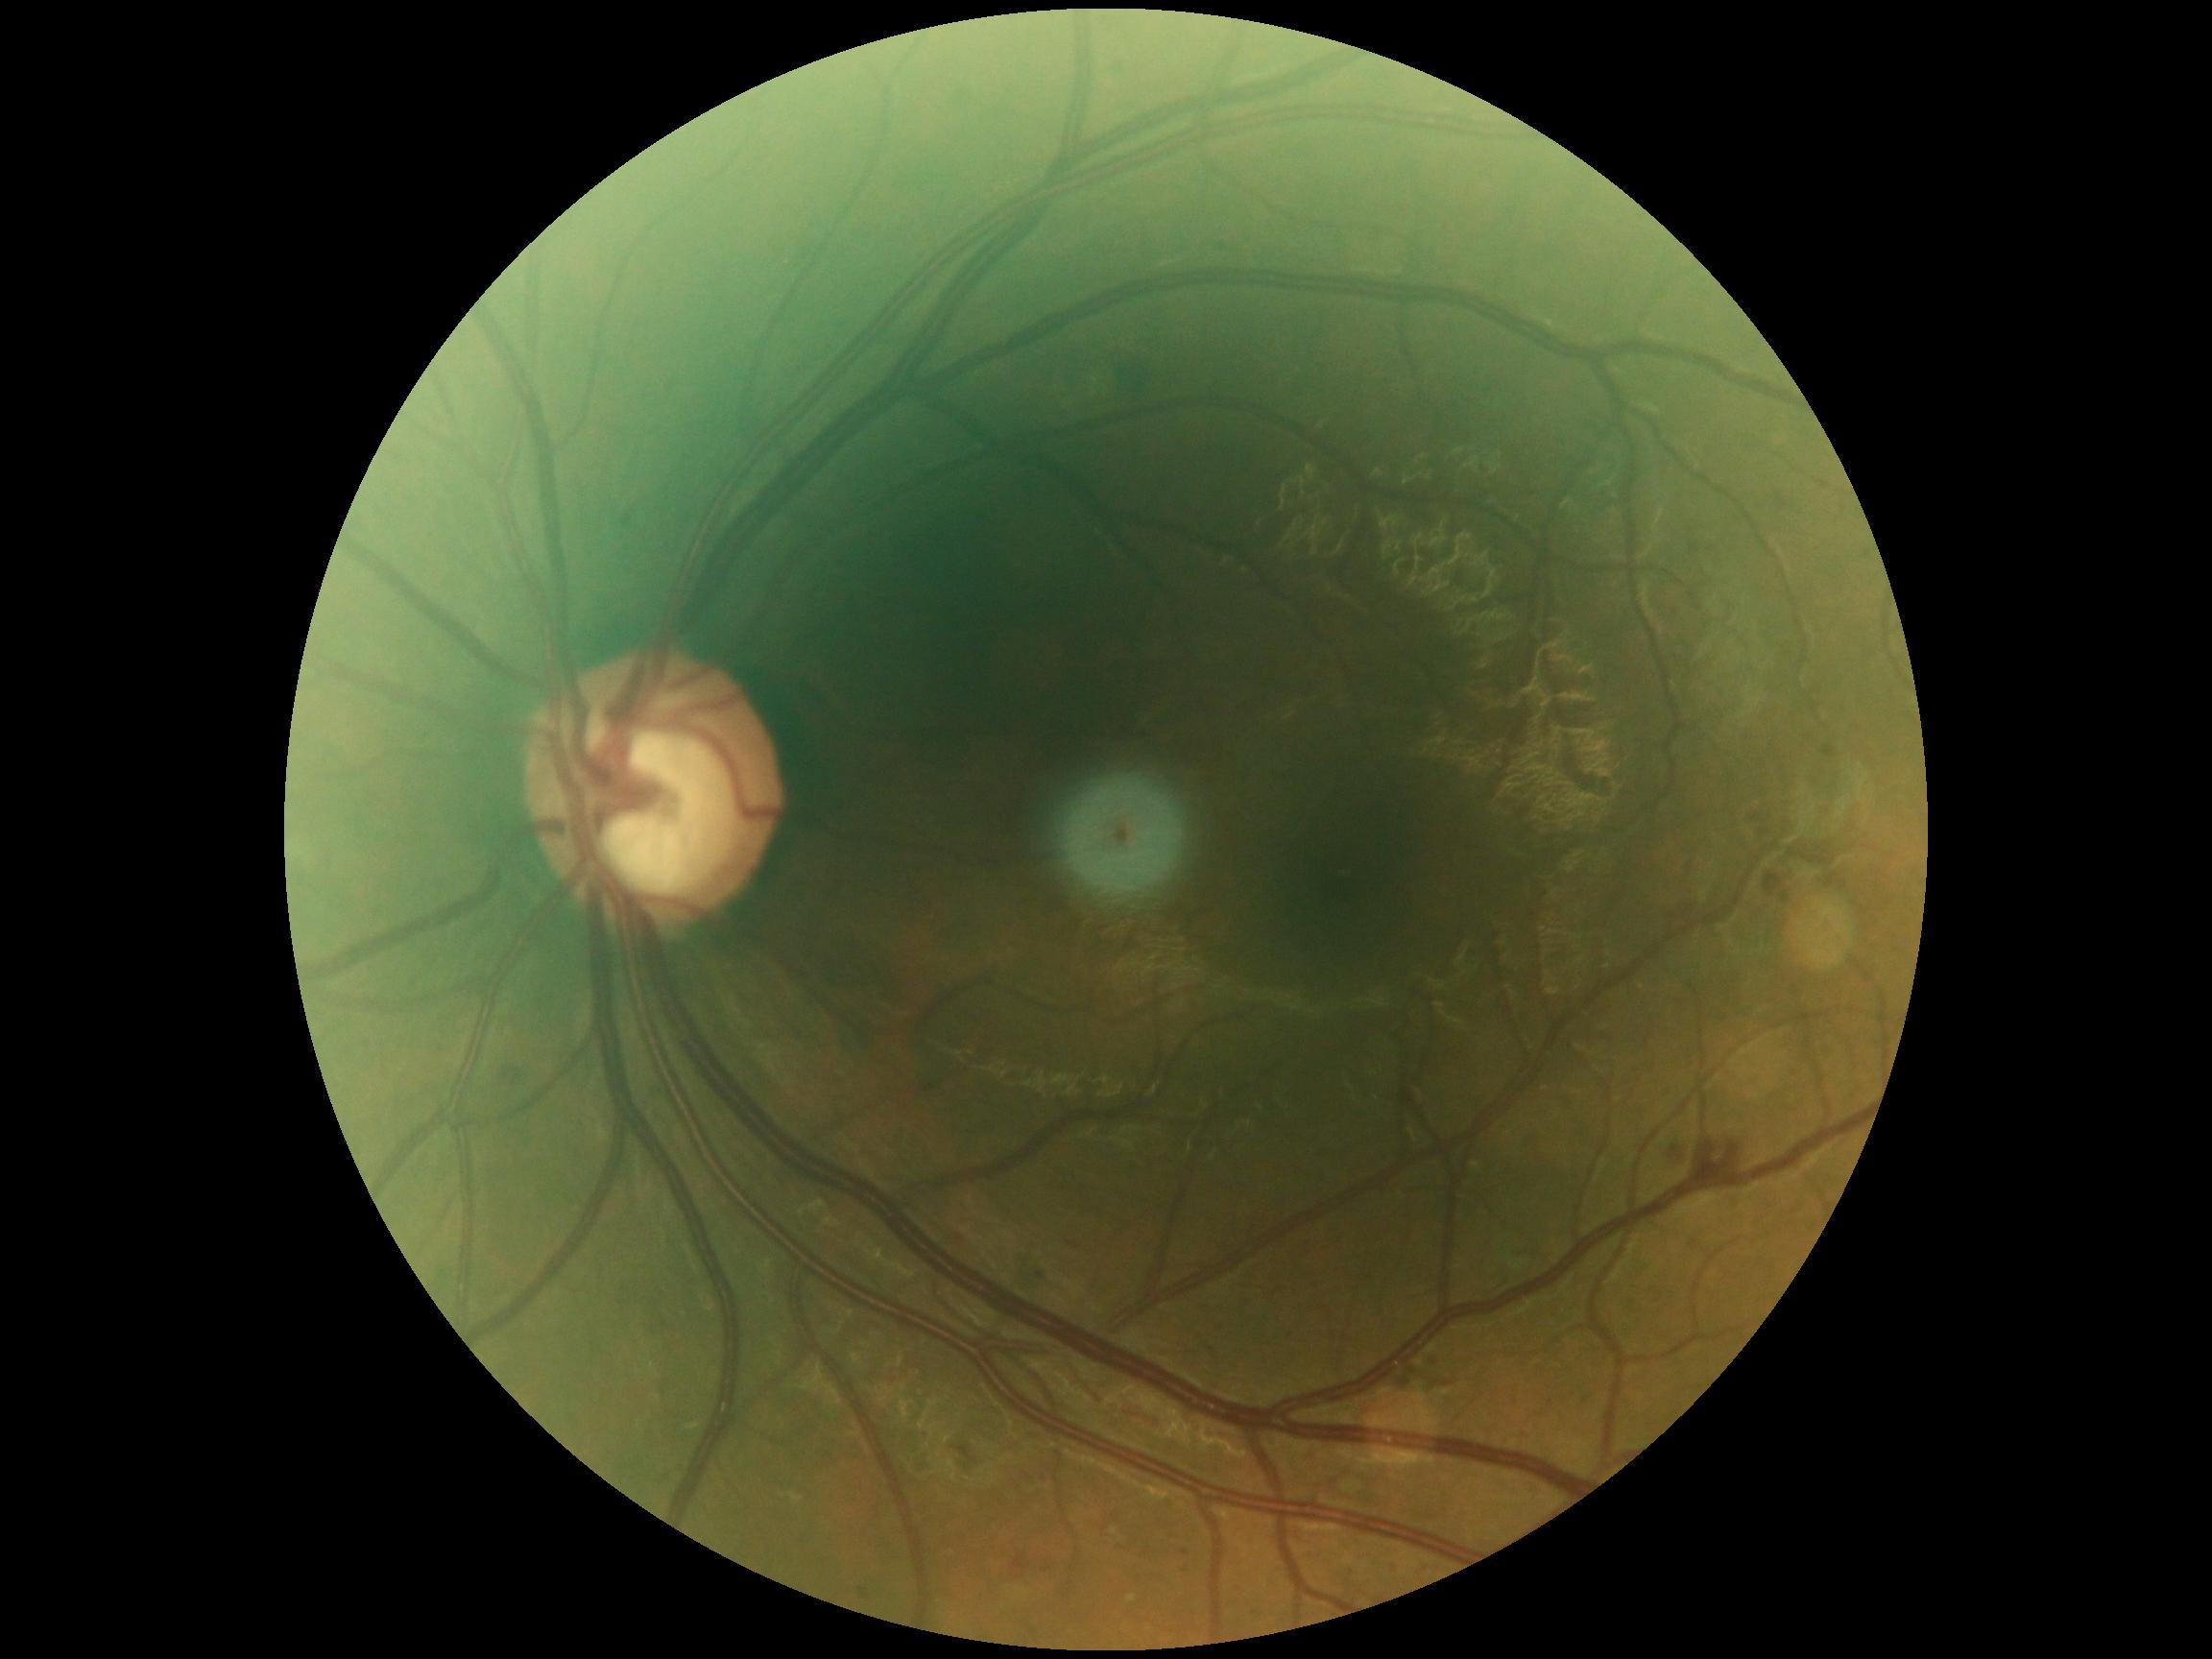 DR class: non-proliferative diabetic retinopathy; DR: moderate non-proliferative diabetic retinopathy (grade 2).